Wide-field contact fundus photograph of an infant · 1440 x 1080 pixels: 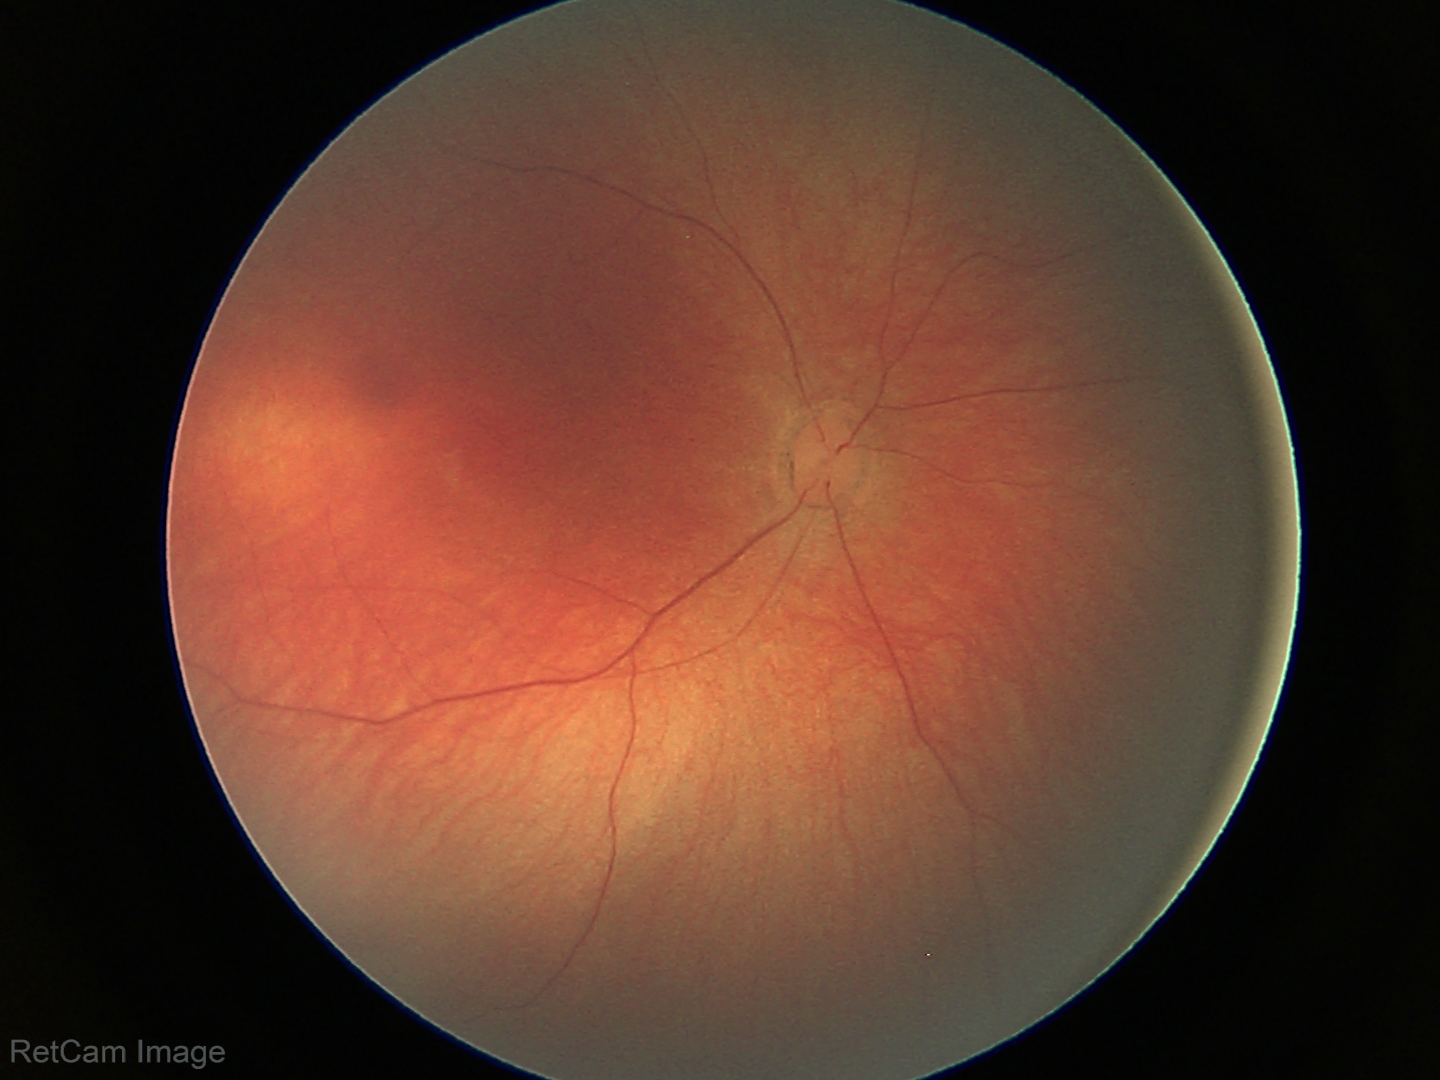
Screening diagnosis: physiological retinal finding.